1659x2212px · color fundus photograph: 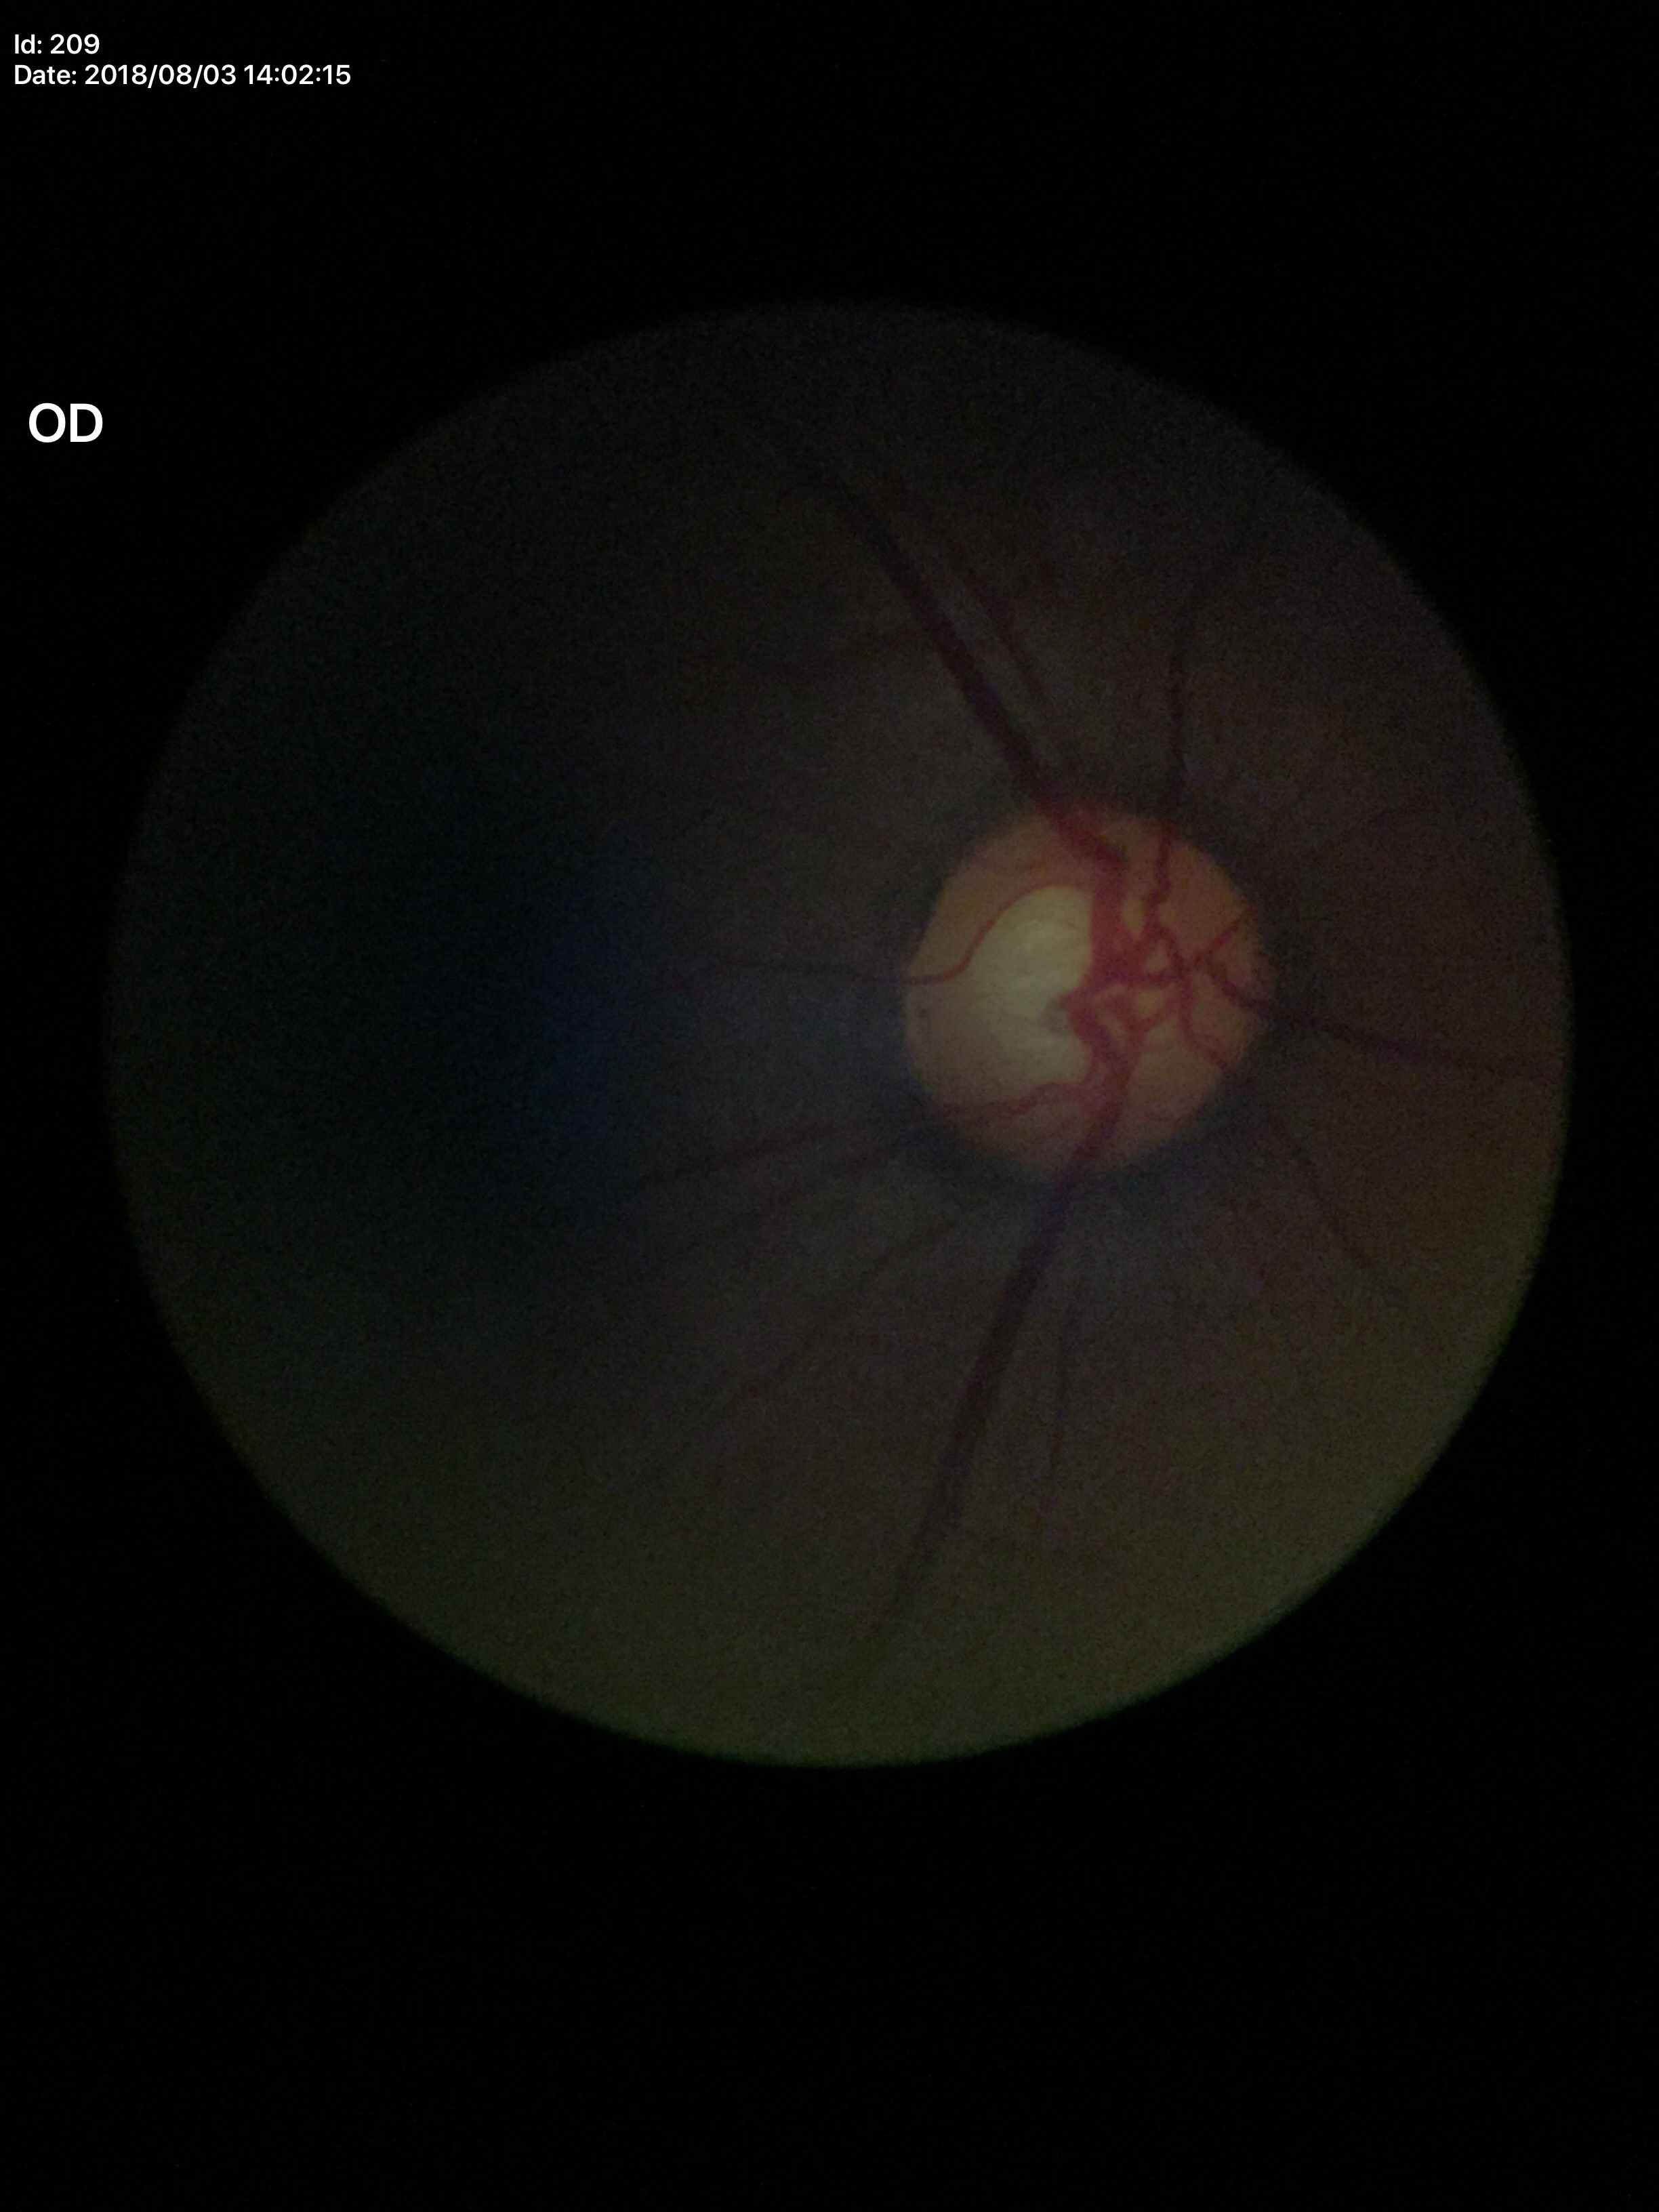
Glaucoma evaluation: suspect, vertical cup-to-disc ratio: 0.63.